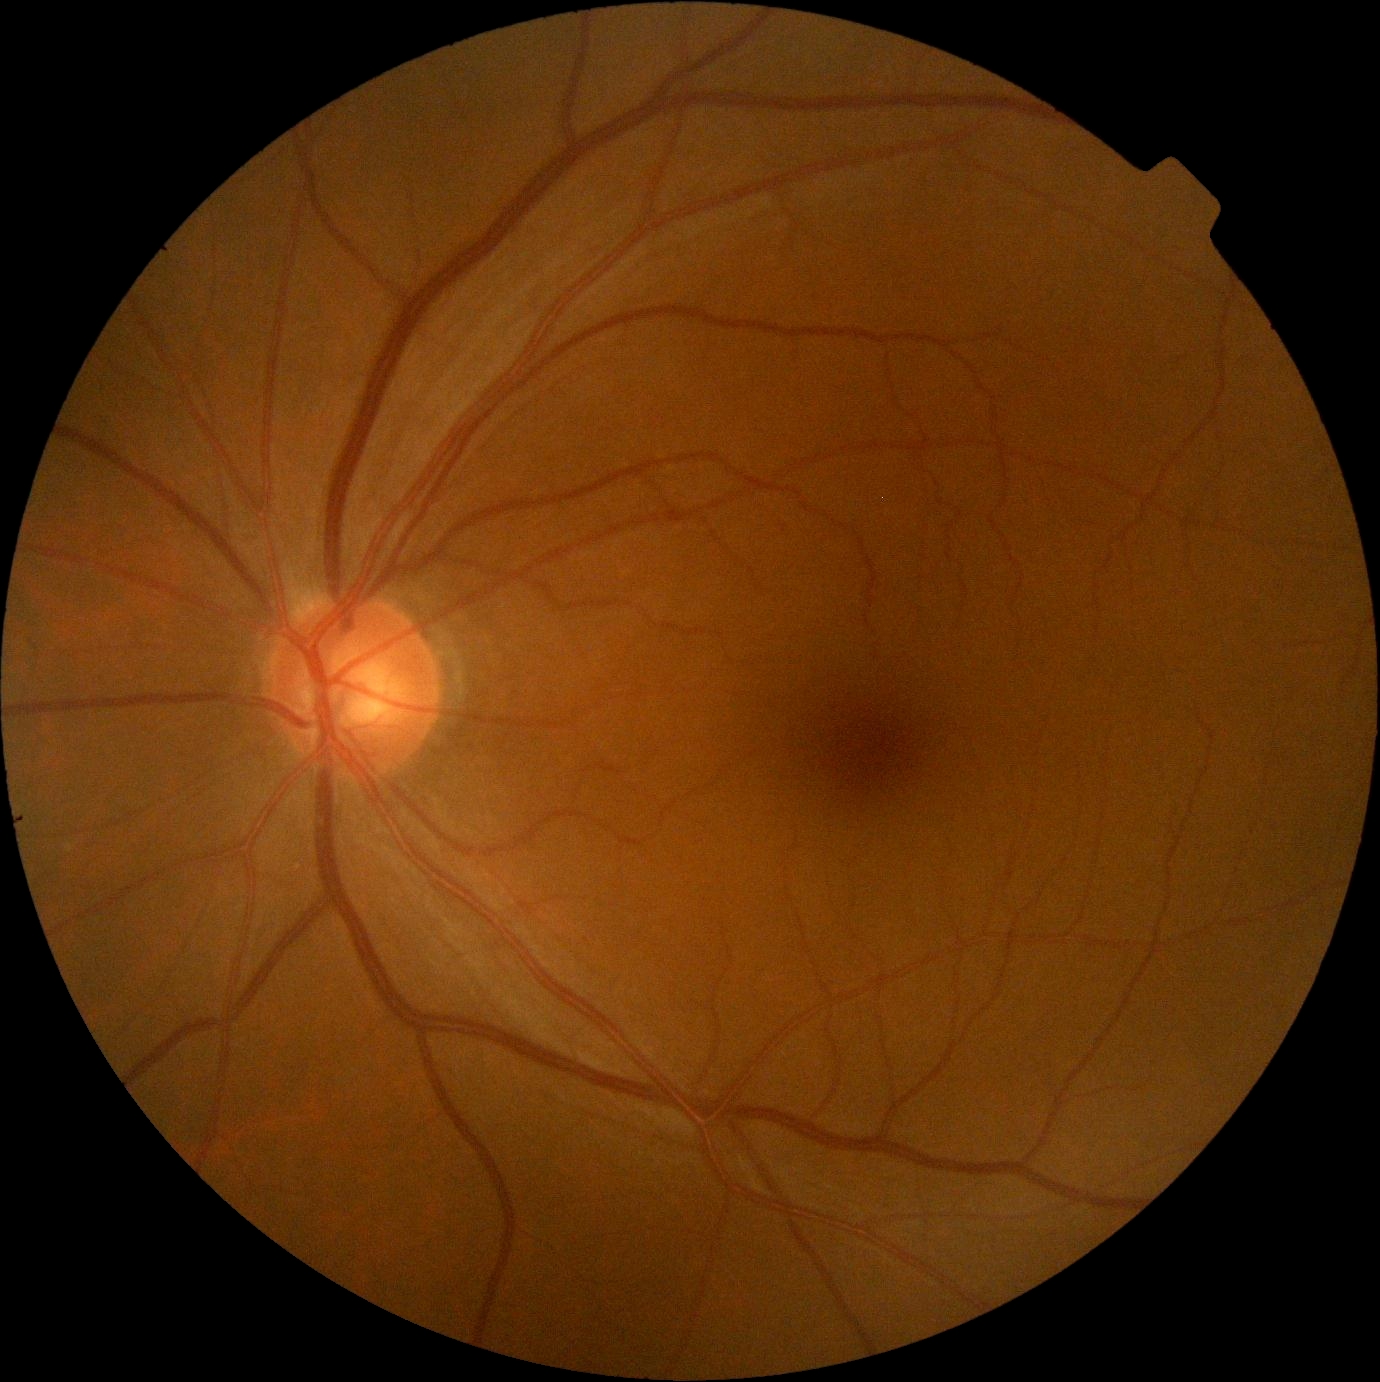

diabetic retinopathy severity@grade 0 (no apparent retinopathy).